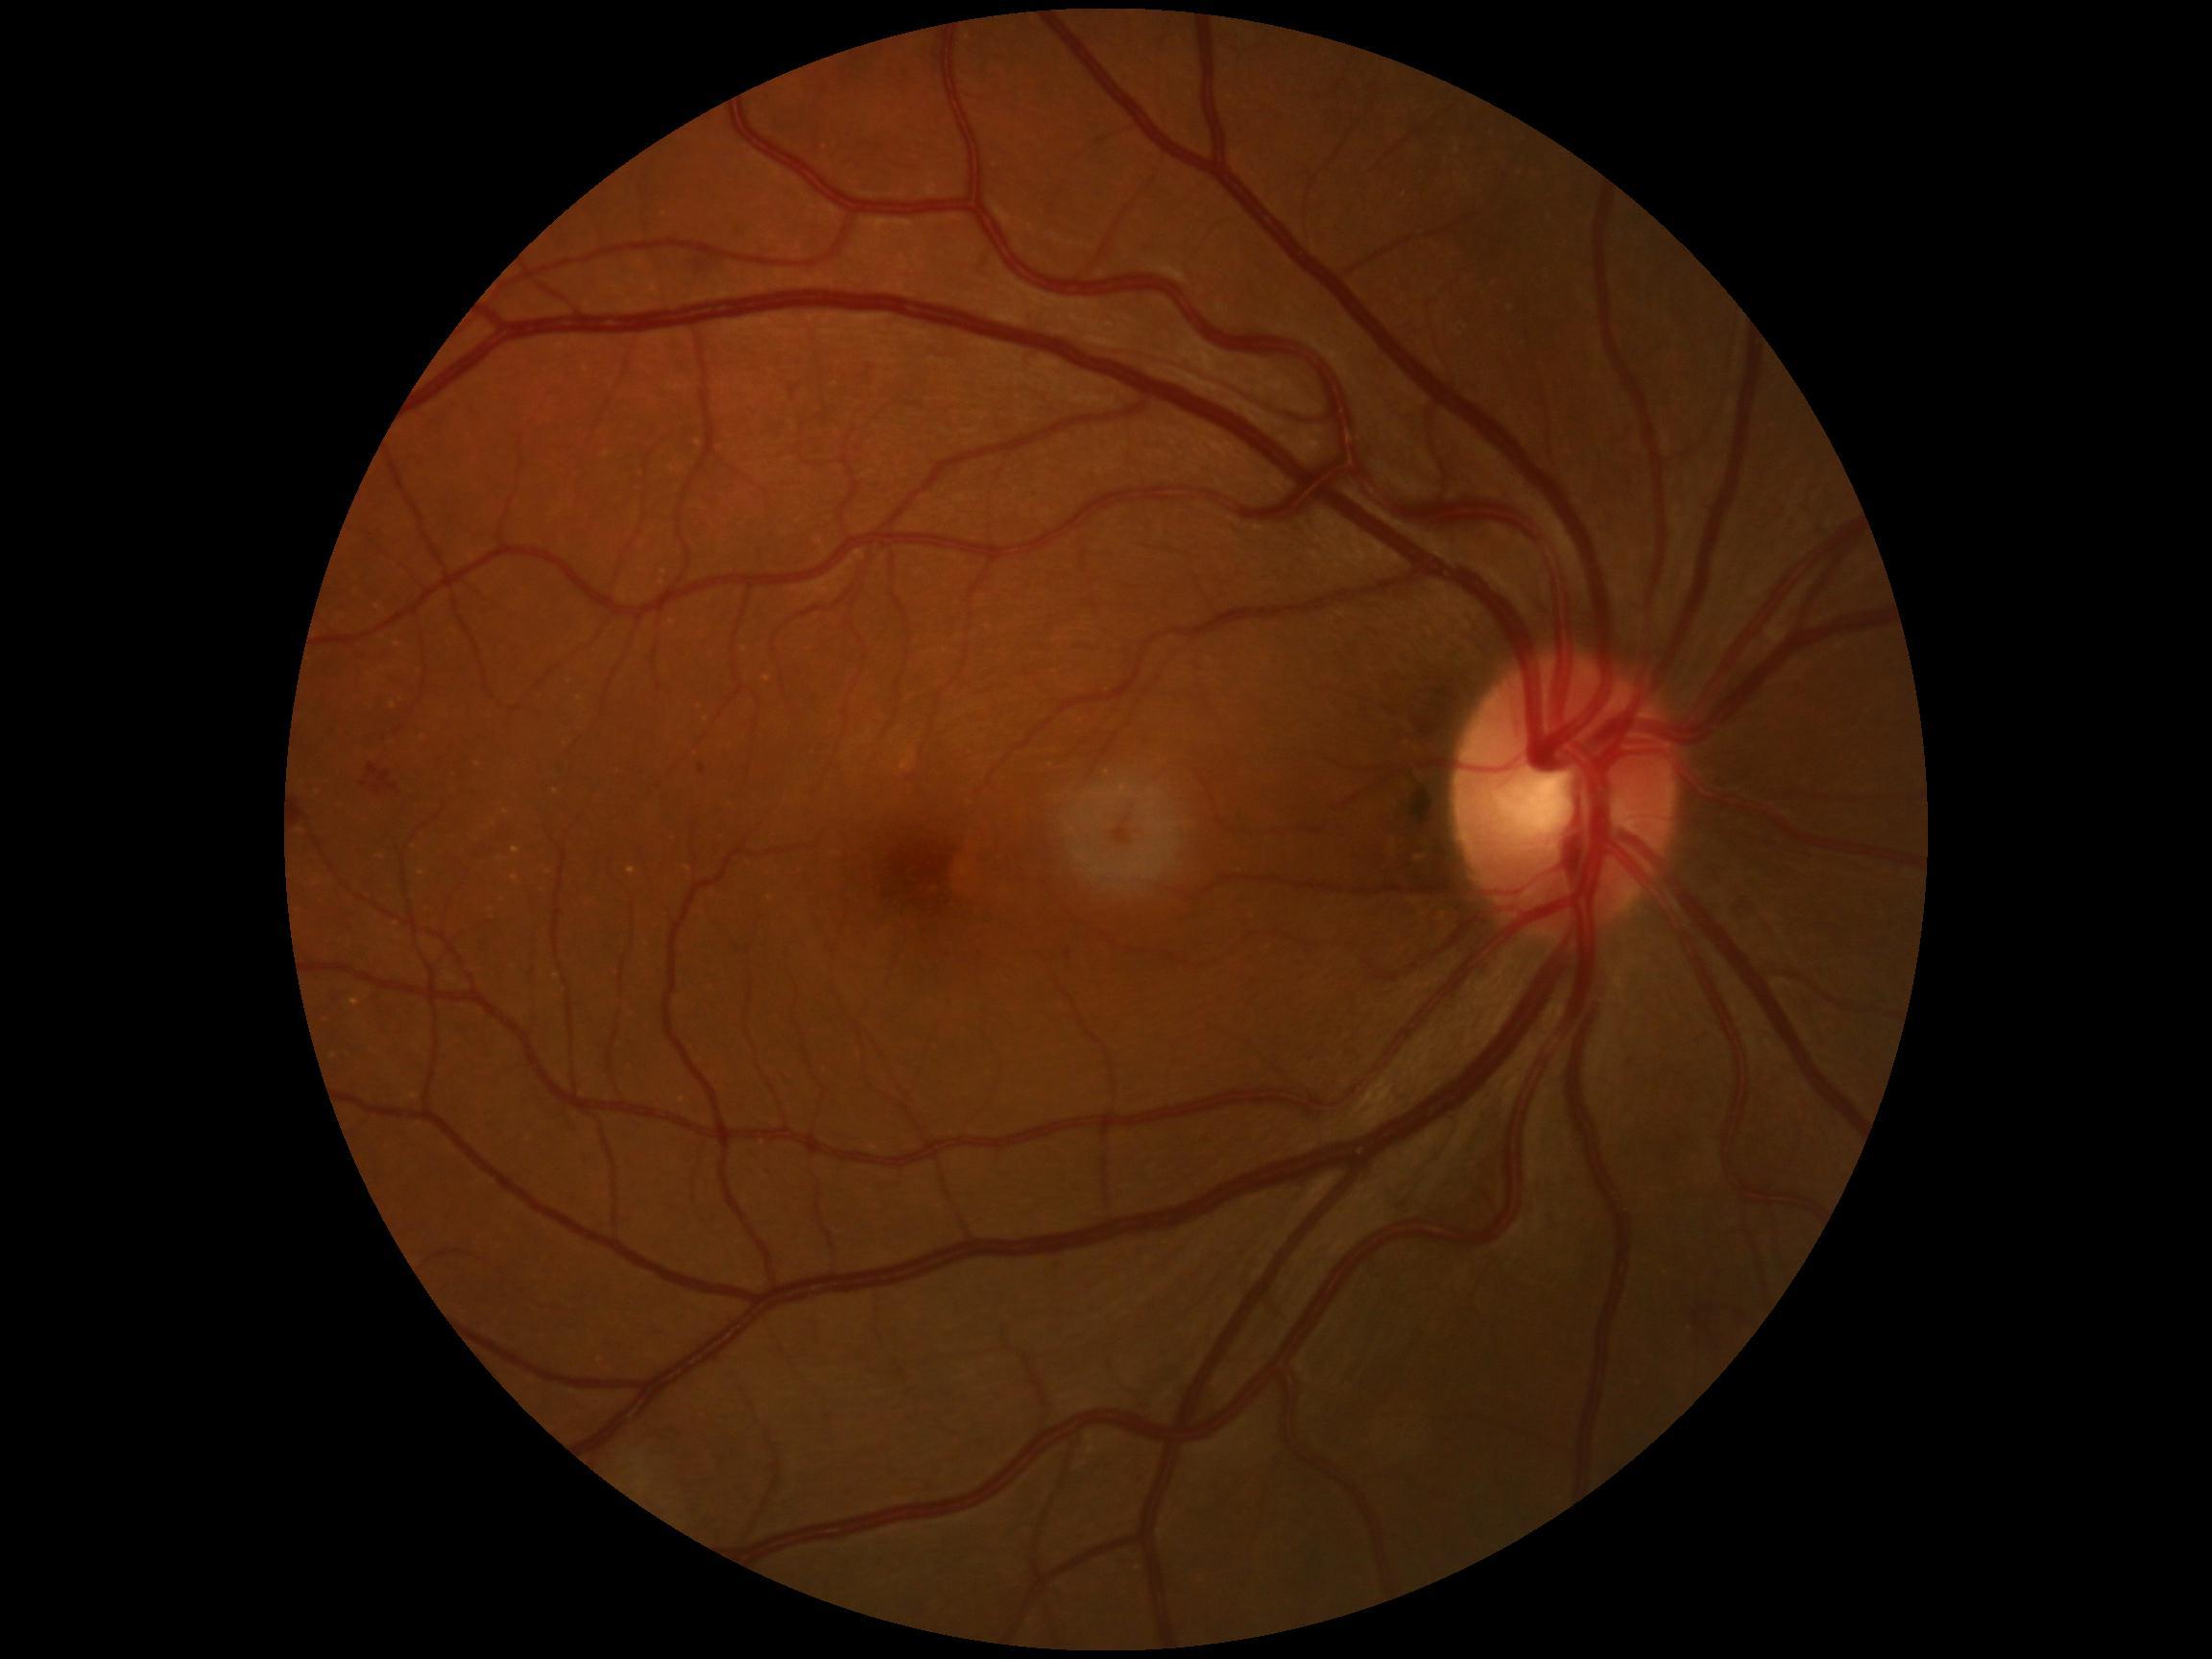

<lesions>
  <dr_grade>2</dr_grade>
  <se />
  <ma>[left=700, top=763, right=708, bottom=775]</ma>
  <he>[left=367, top=765, right=397, bottom=794], [left=1692, top=1300, right=1751, bottom=1335]</he>
  <he_small_approx>[365,784]</he_small_approx>
  <ex />
</lesions>